45° field of view: 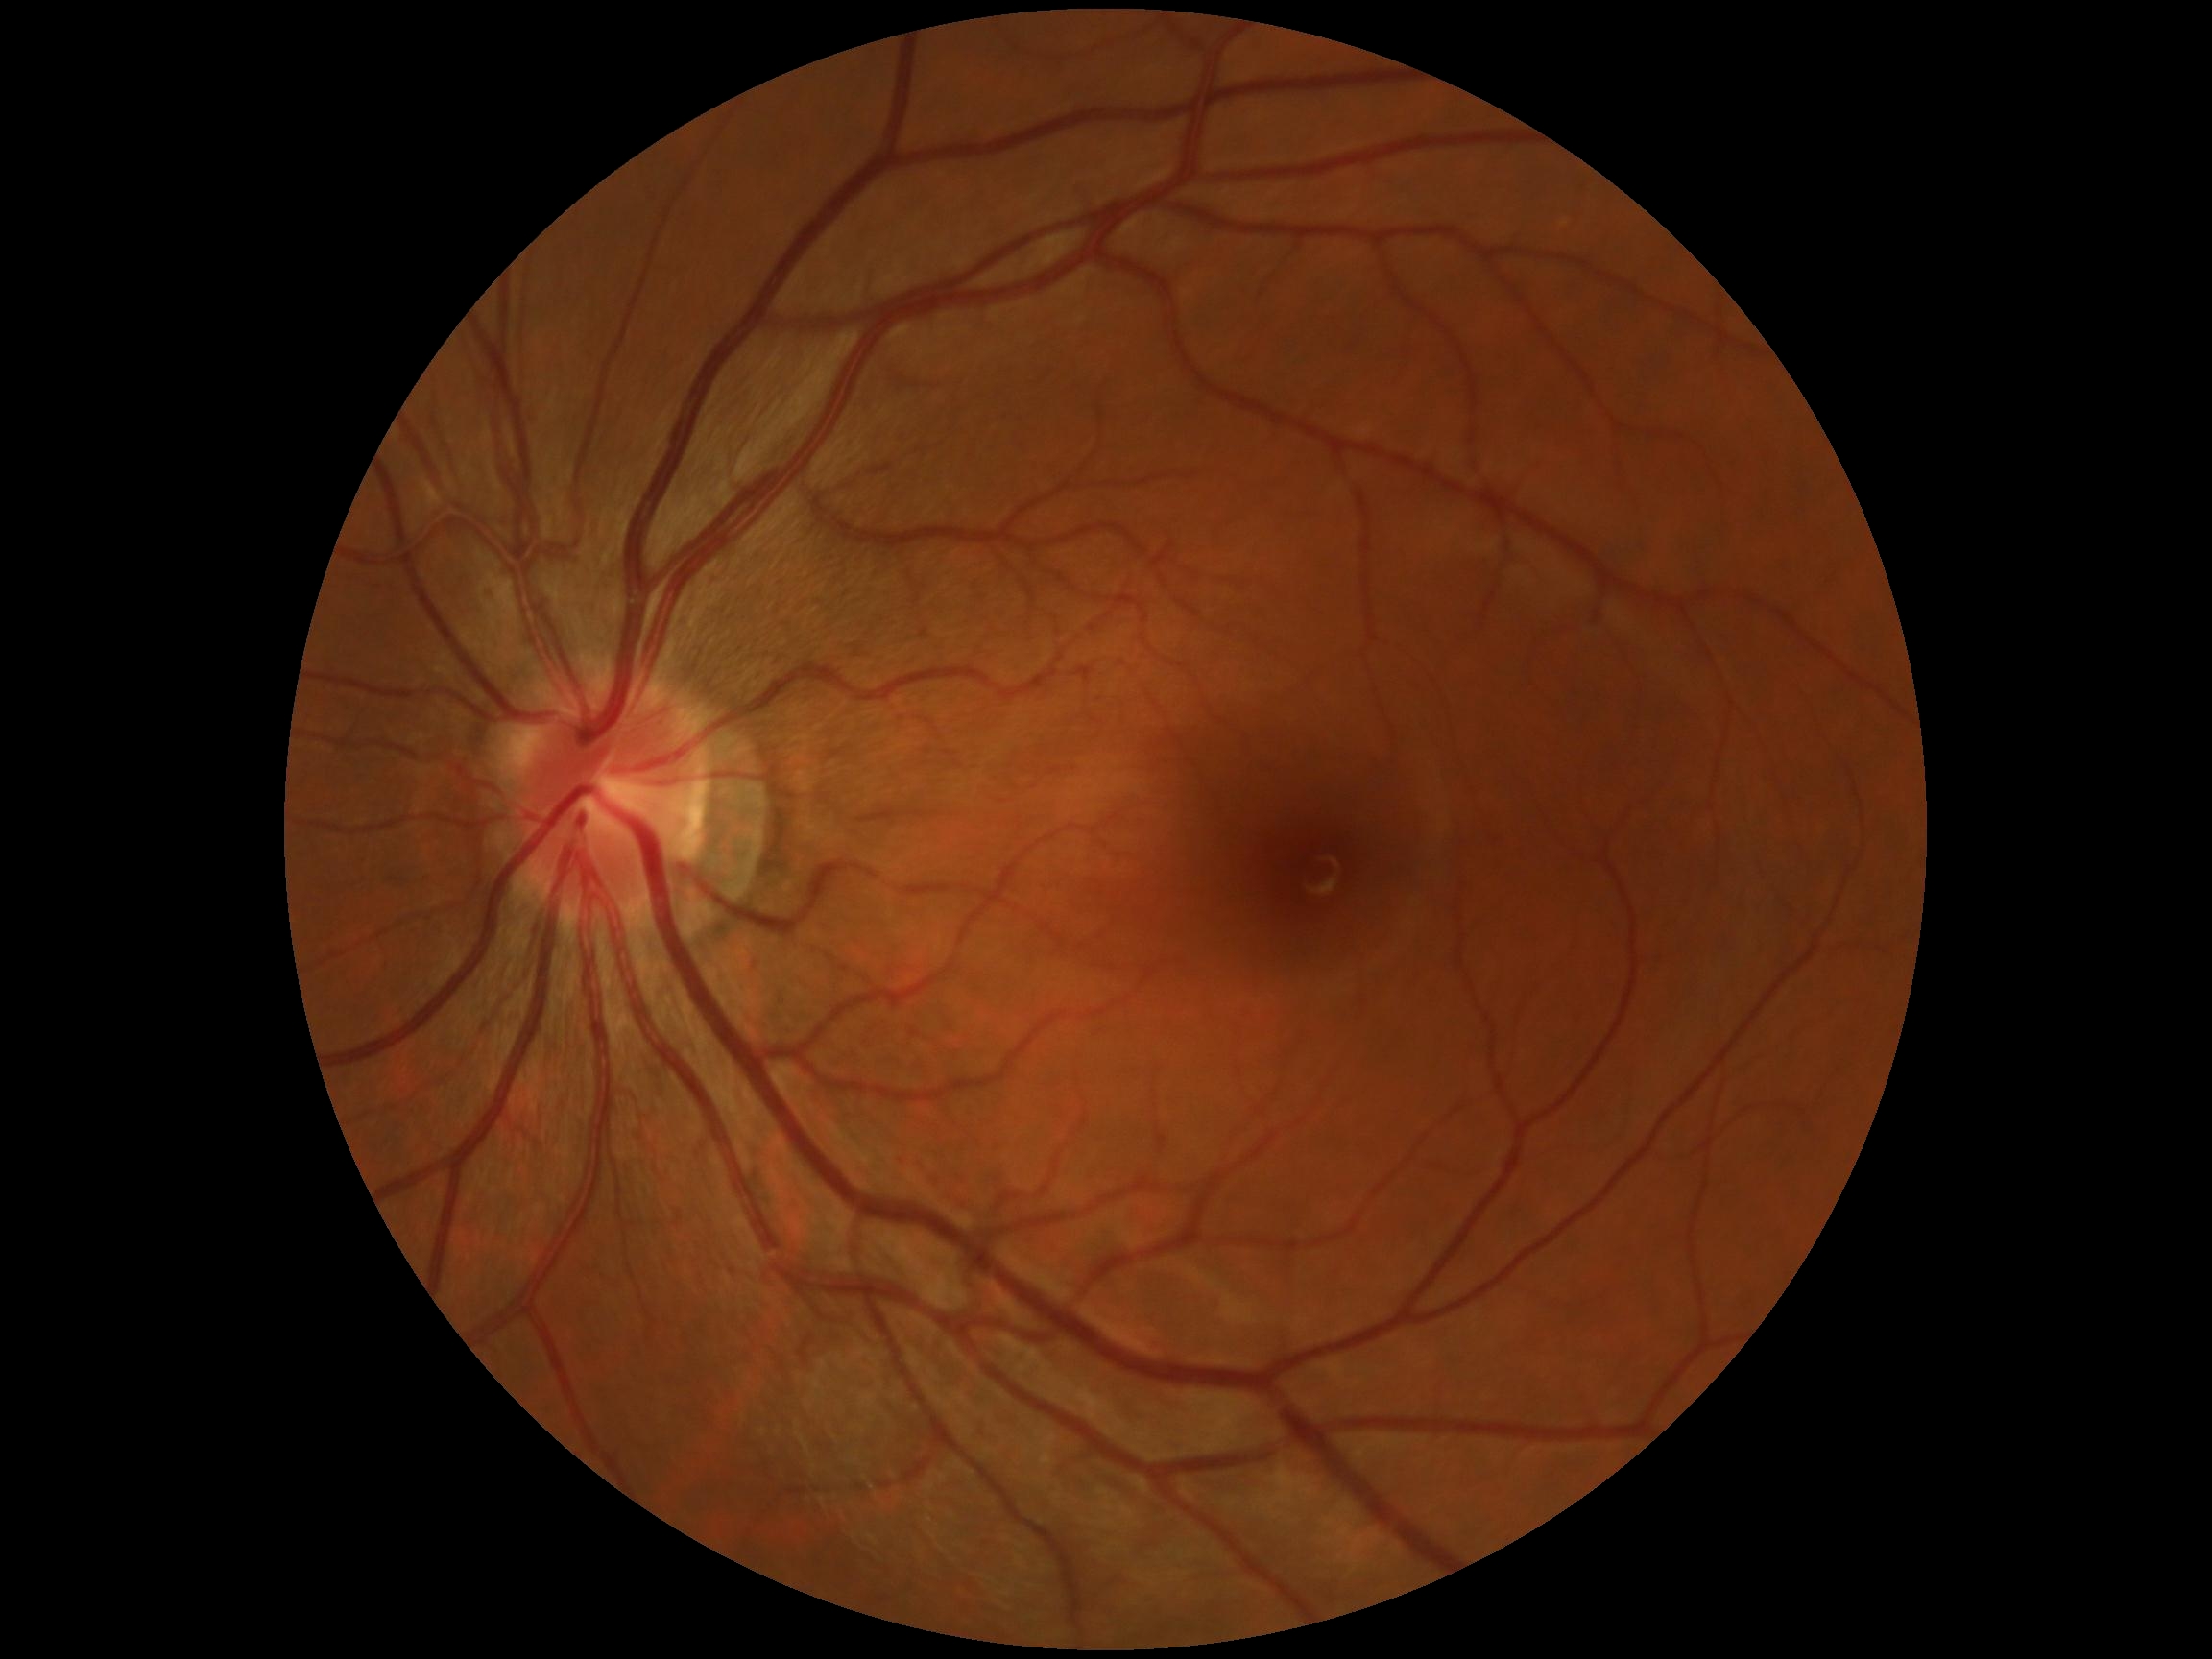 Diabetic retinopathy severity: grade 0 (no apparent retinopathy).
No signs of diabetic retinopathy.